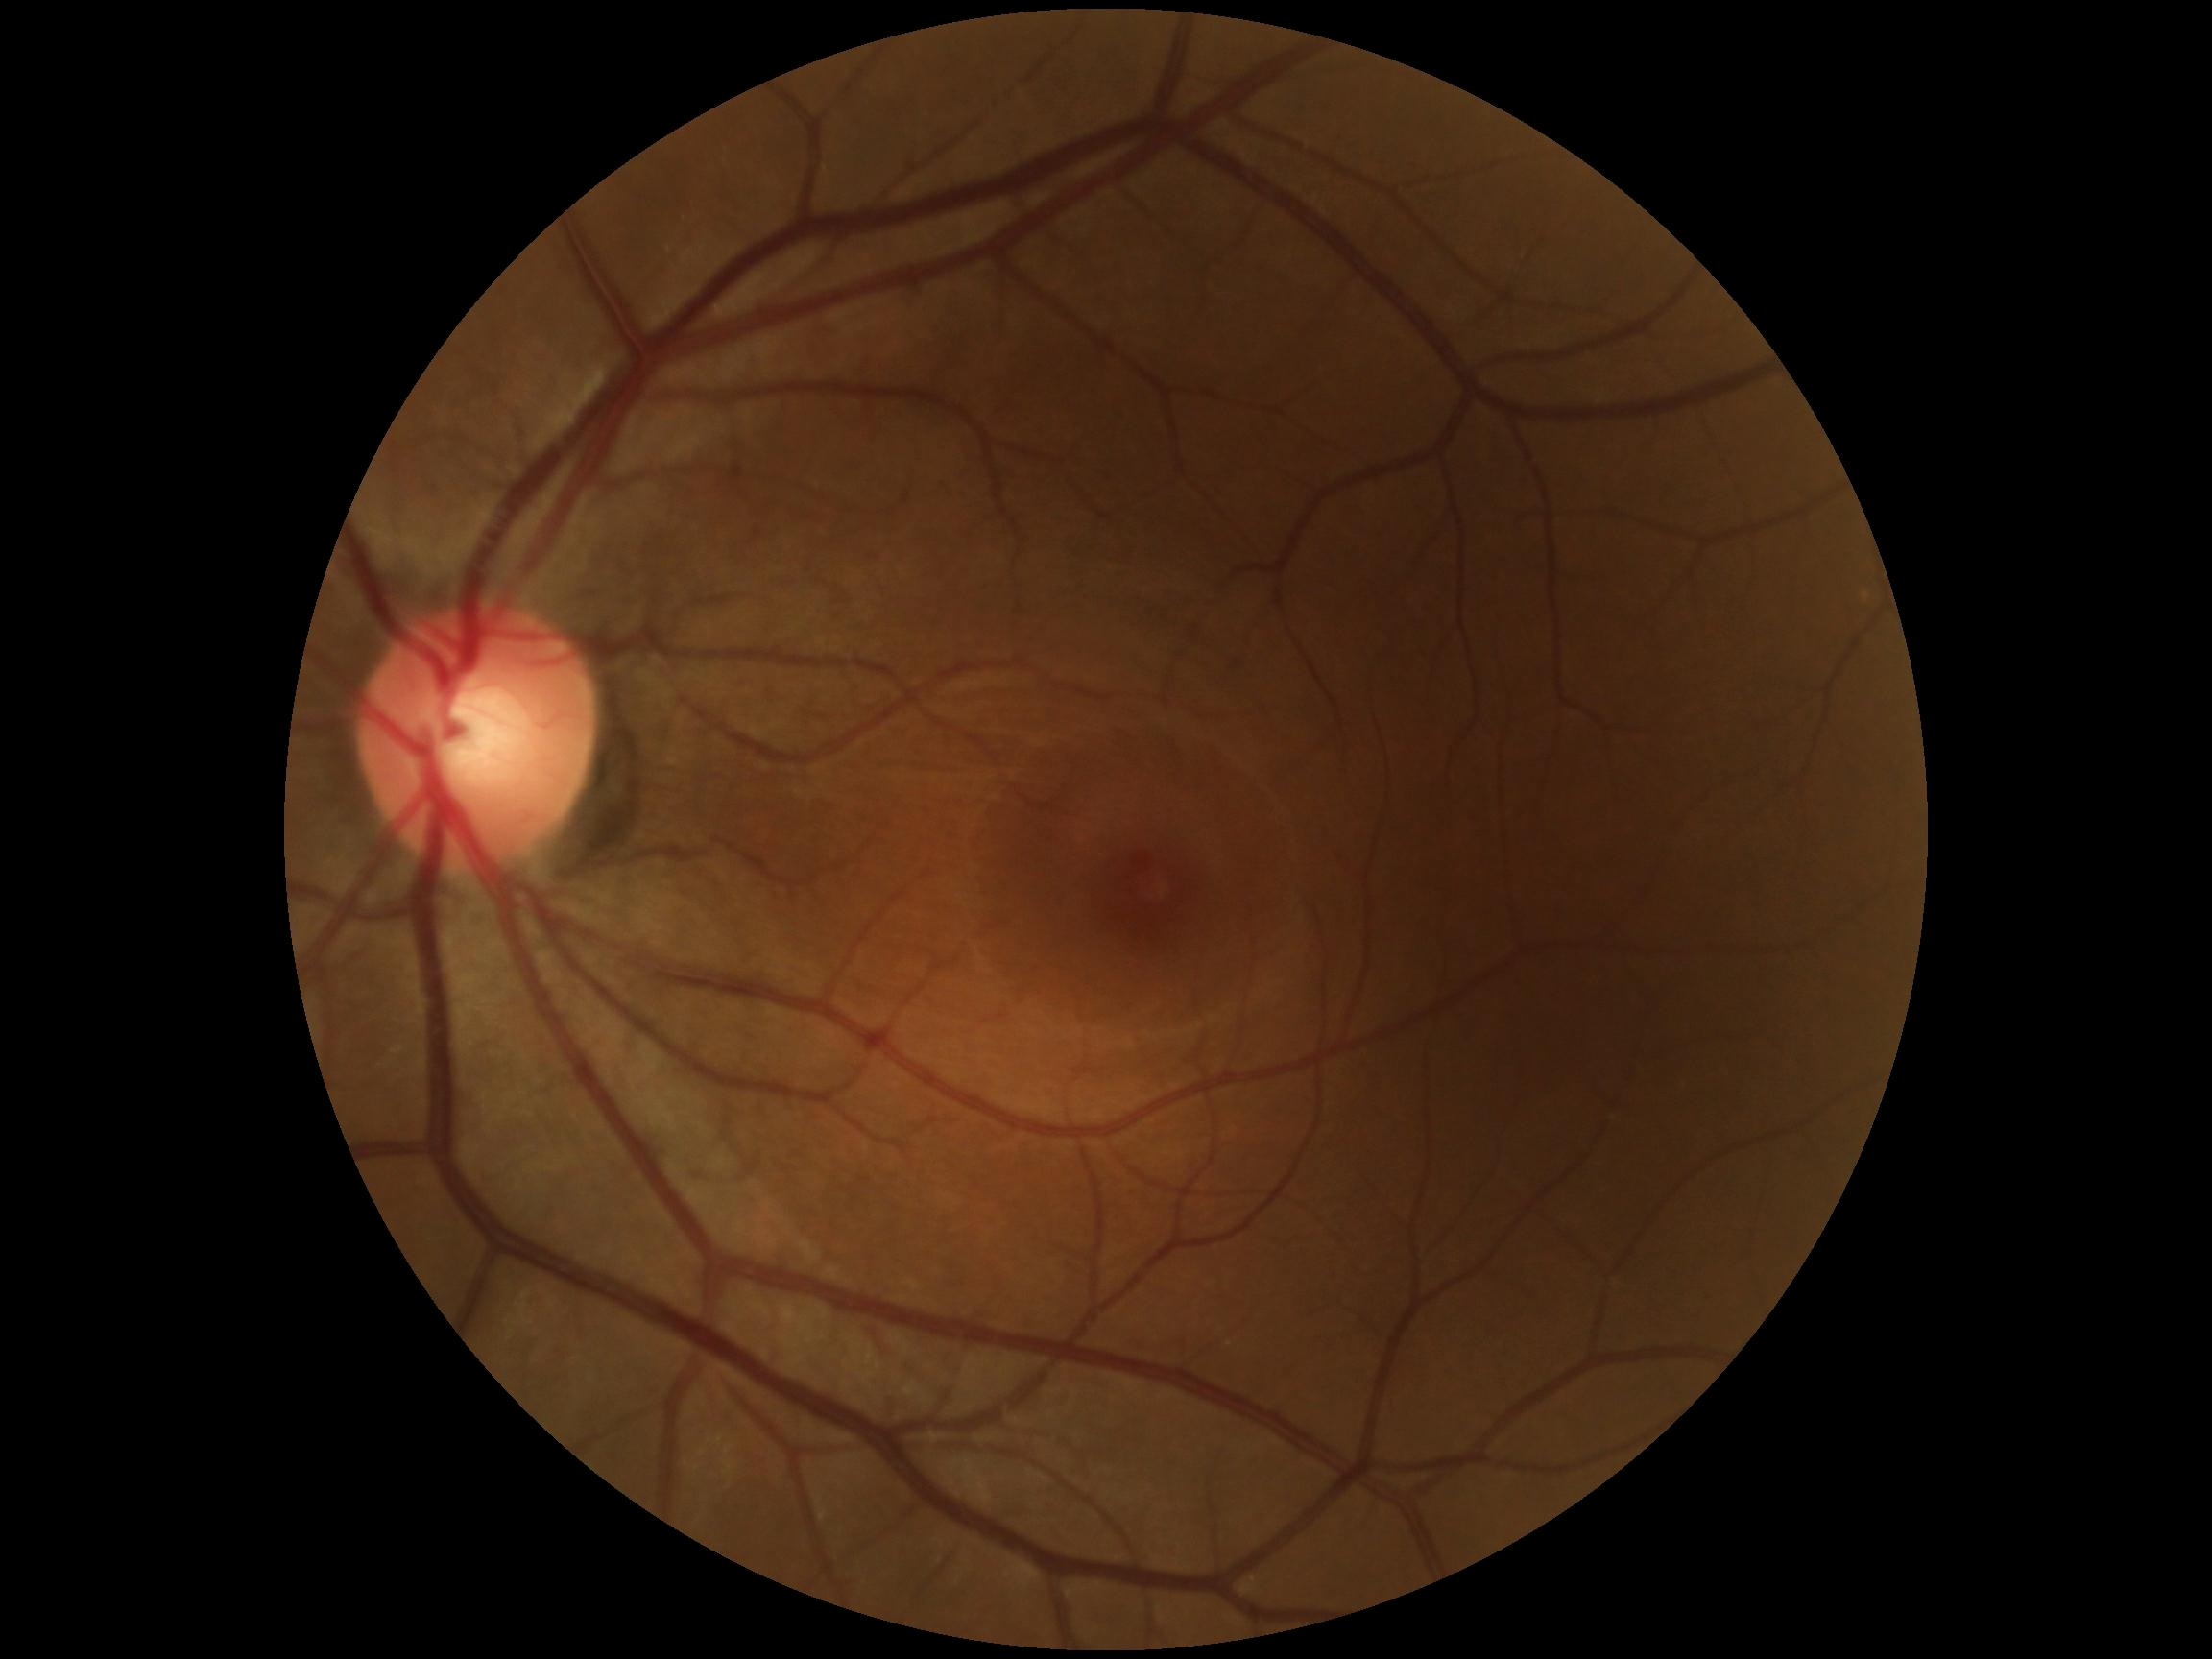
Diabetic retinopathy grade is 0 (no apparent retinopathy).
No apparent diabetic retinopathy.